848x848.
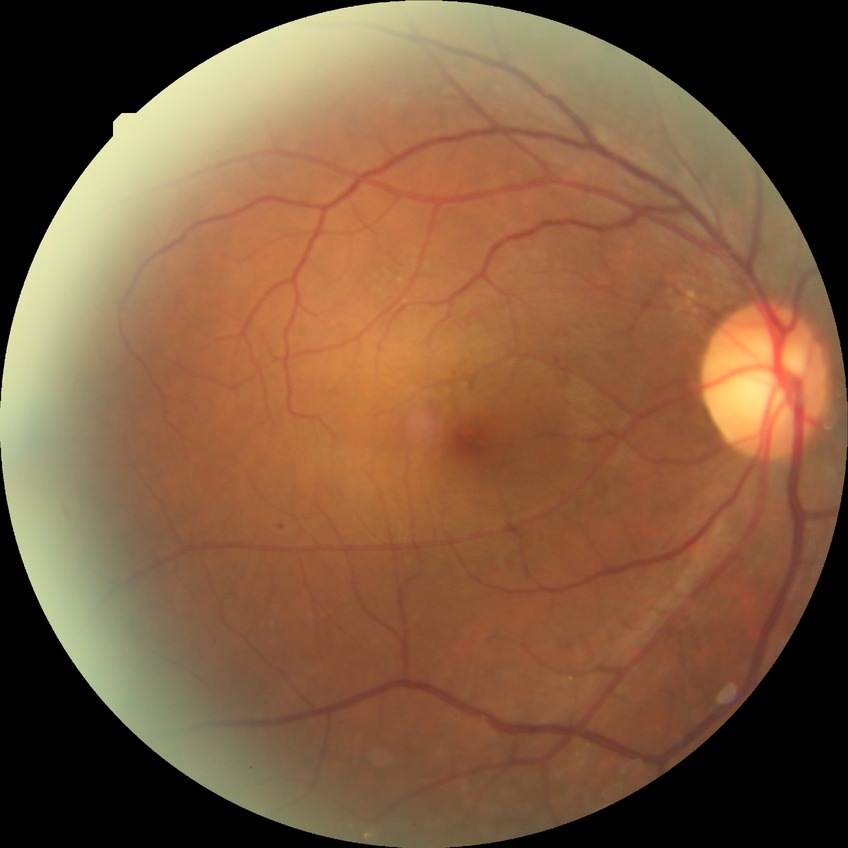

• diabetic retinopathy (DR) — pre-proliferative diabetic retinopathy (PPDR)